Image size 2089x1764 · color fundus image — 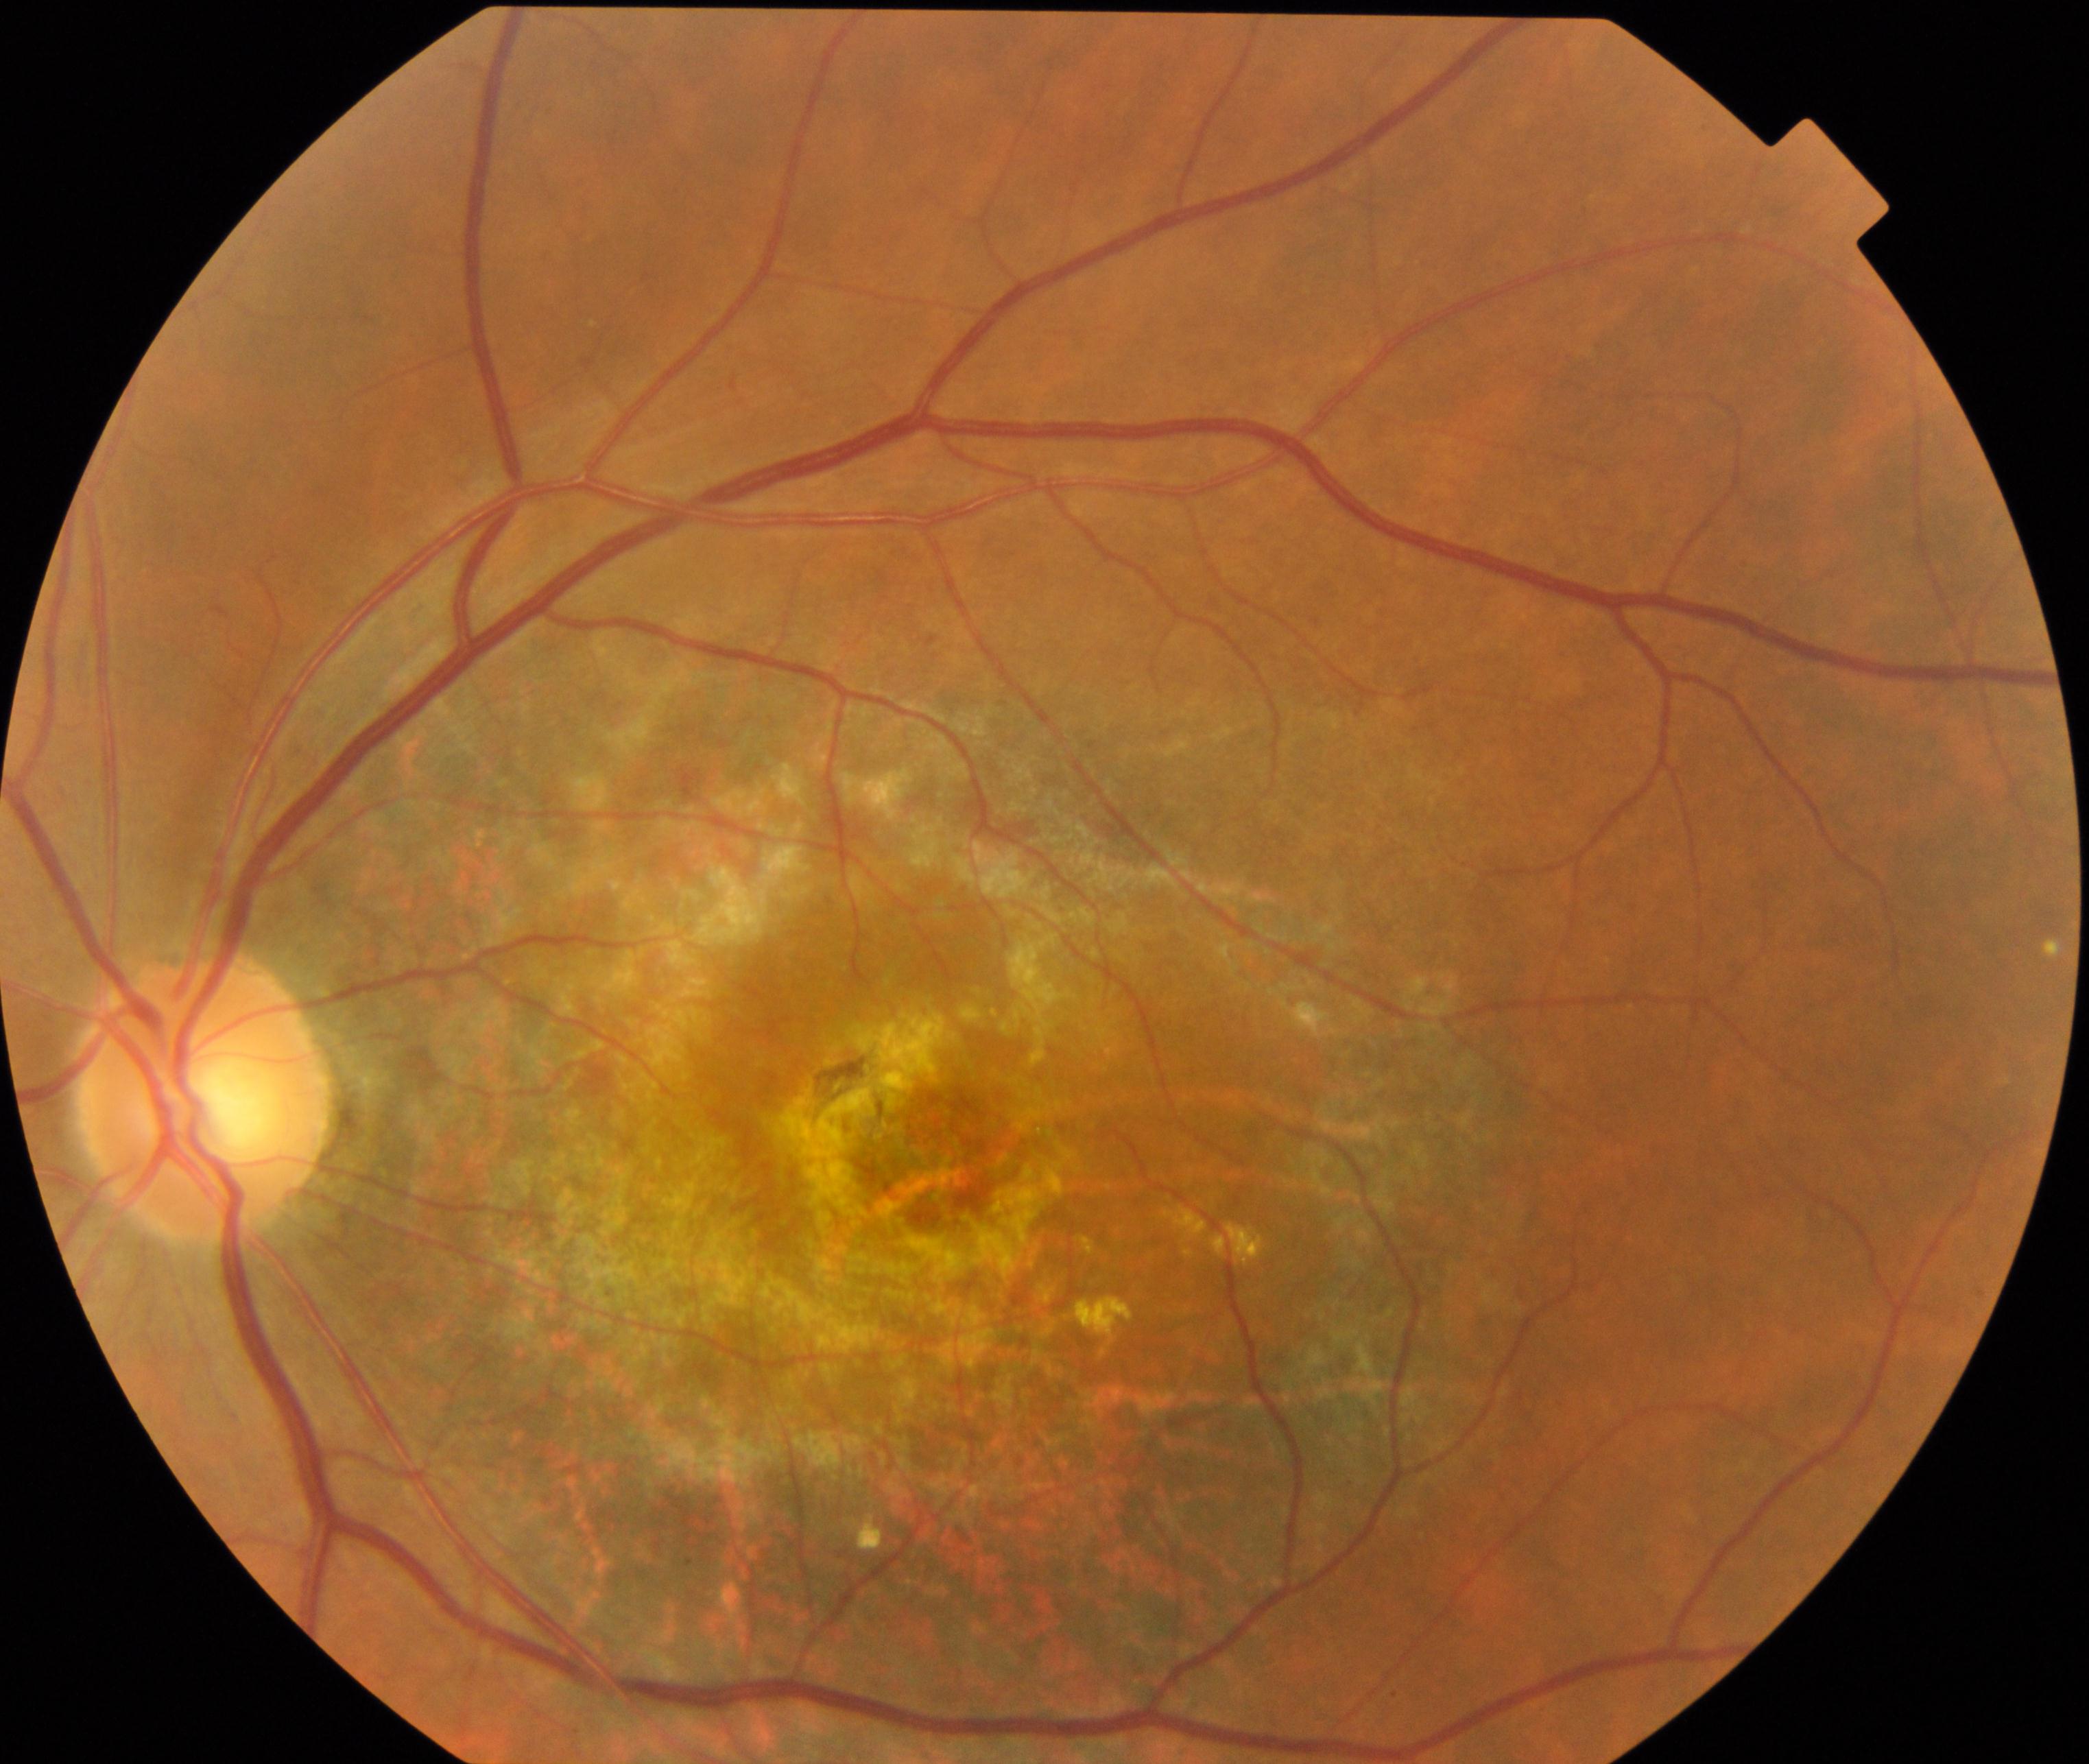

Classification: maculopathy.